NIDEK AFC-230; 848x848px; no pharmacologic dilation; FOV: 45 degrees; posterior pole color fundus photograph: 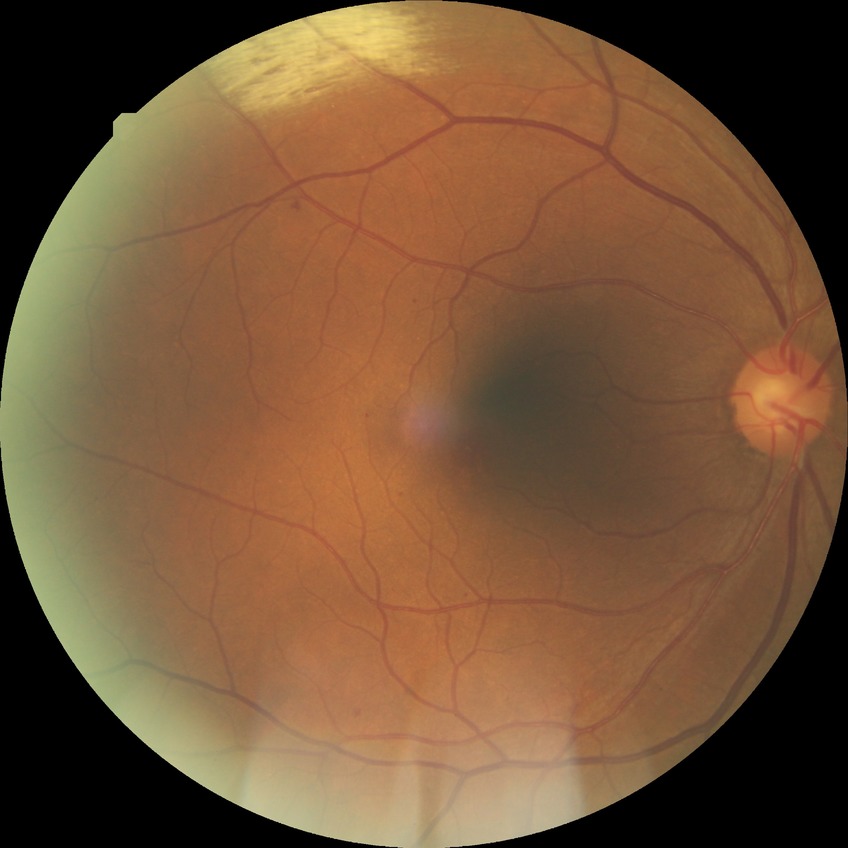 DR severity is SDR.